Image size 1240x1240 · infant wide-field fundus photograph
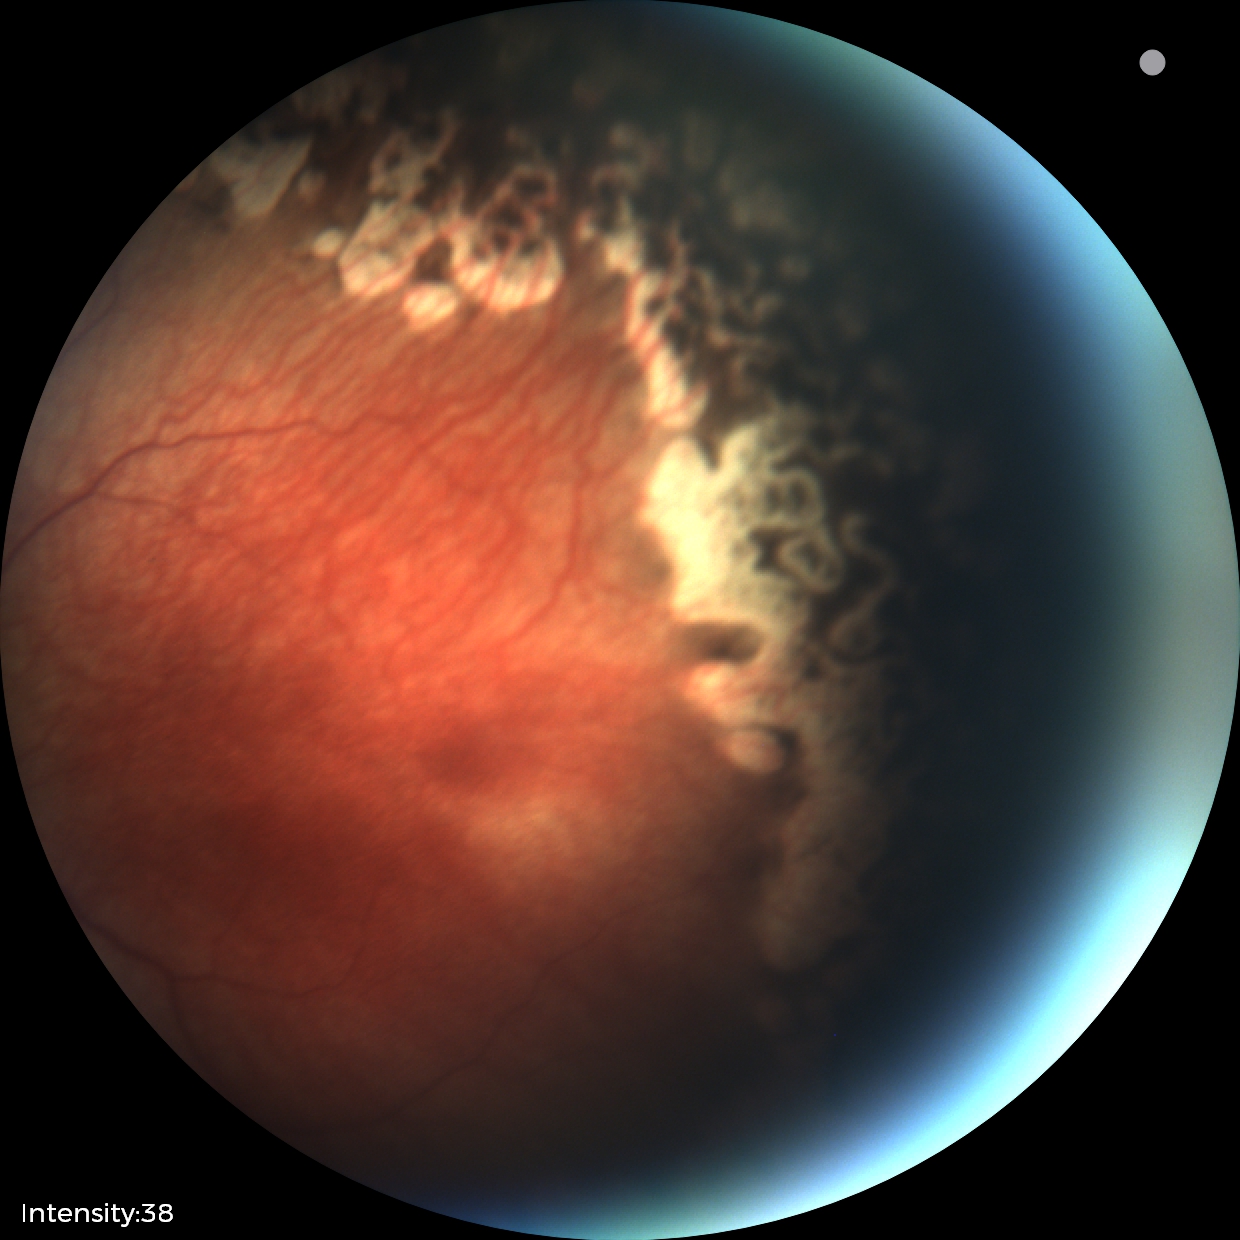 Series diagnosed as status post retinopathy of prematurity.